Retinal fundus photograph, 45-degree field of view, image size 1932x1910:
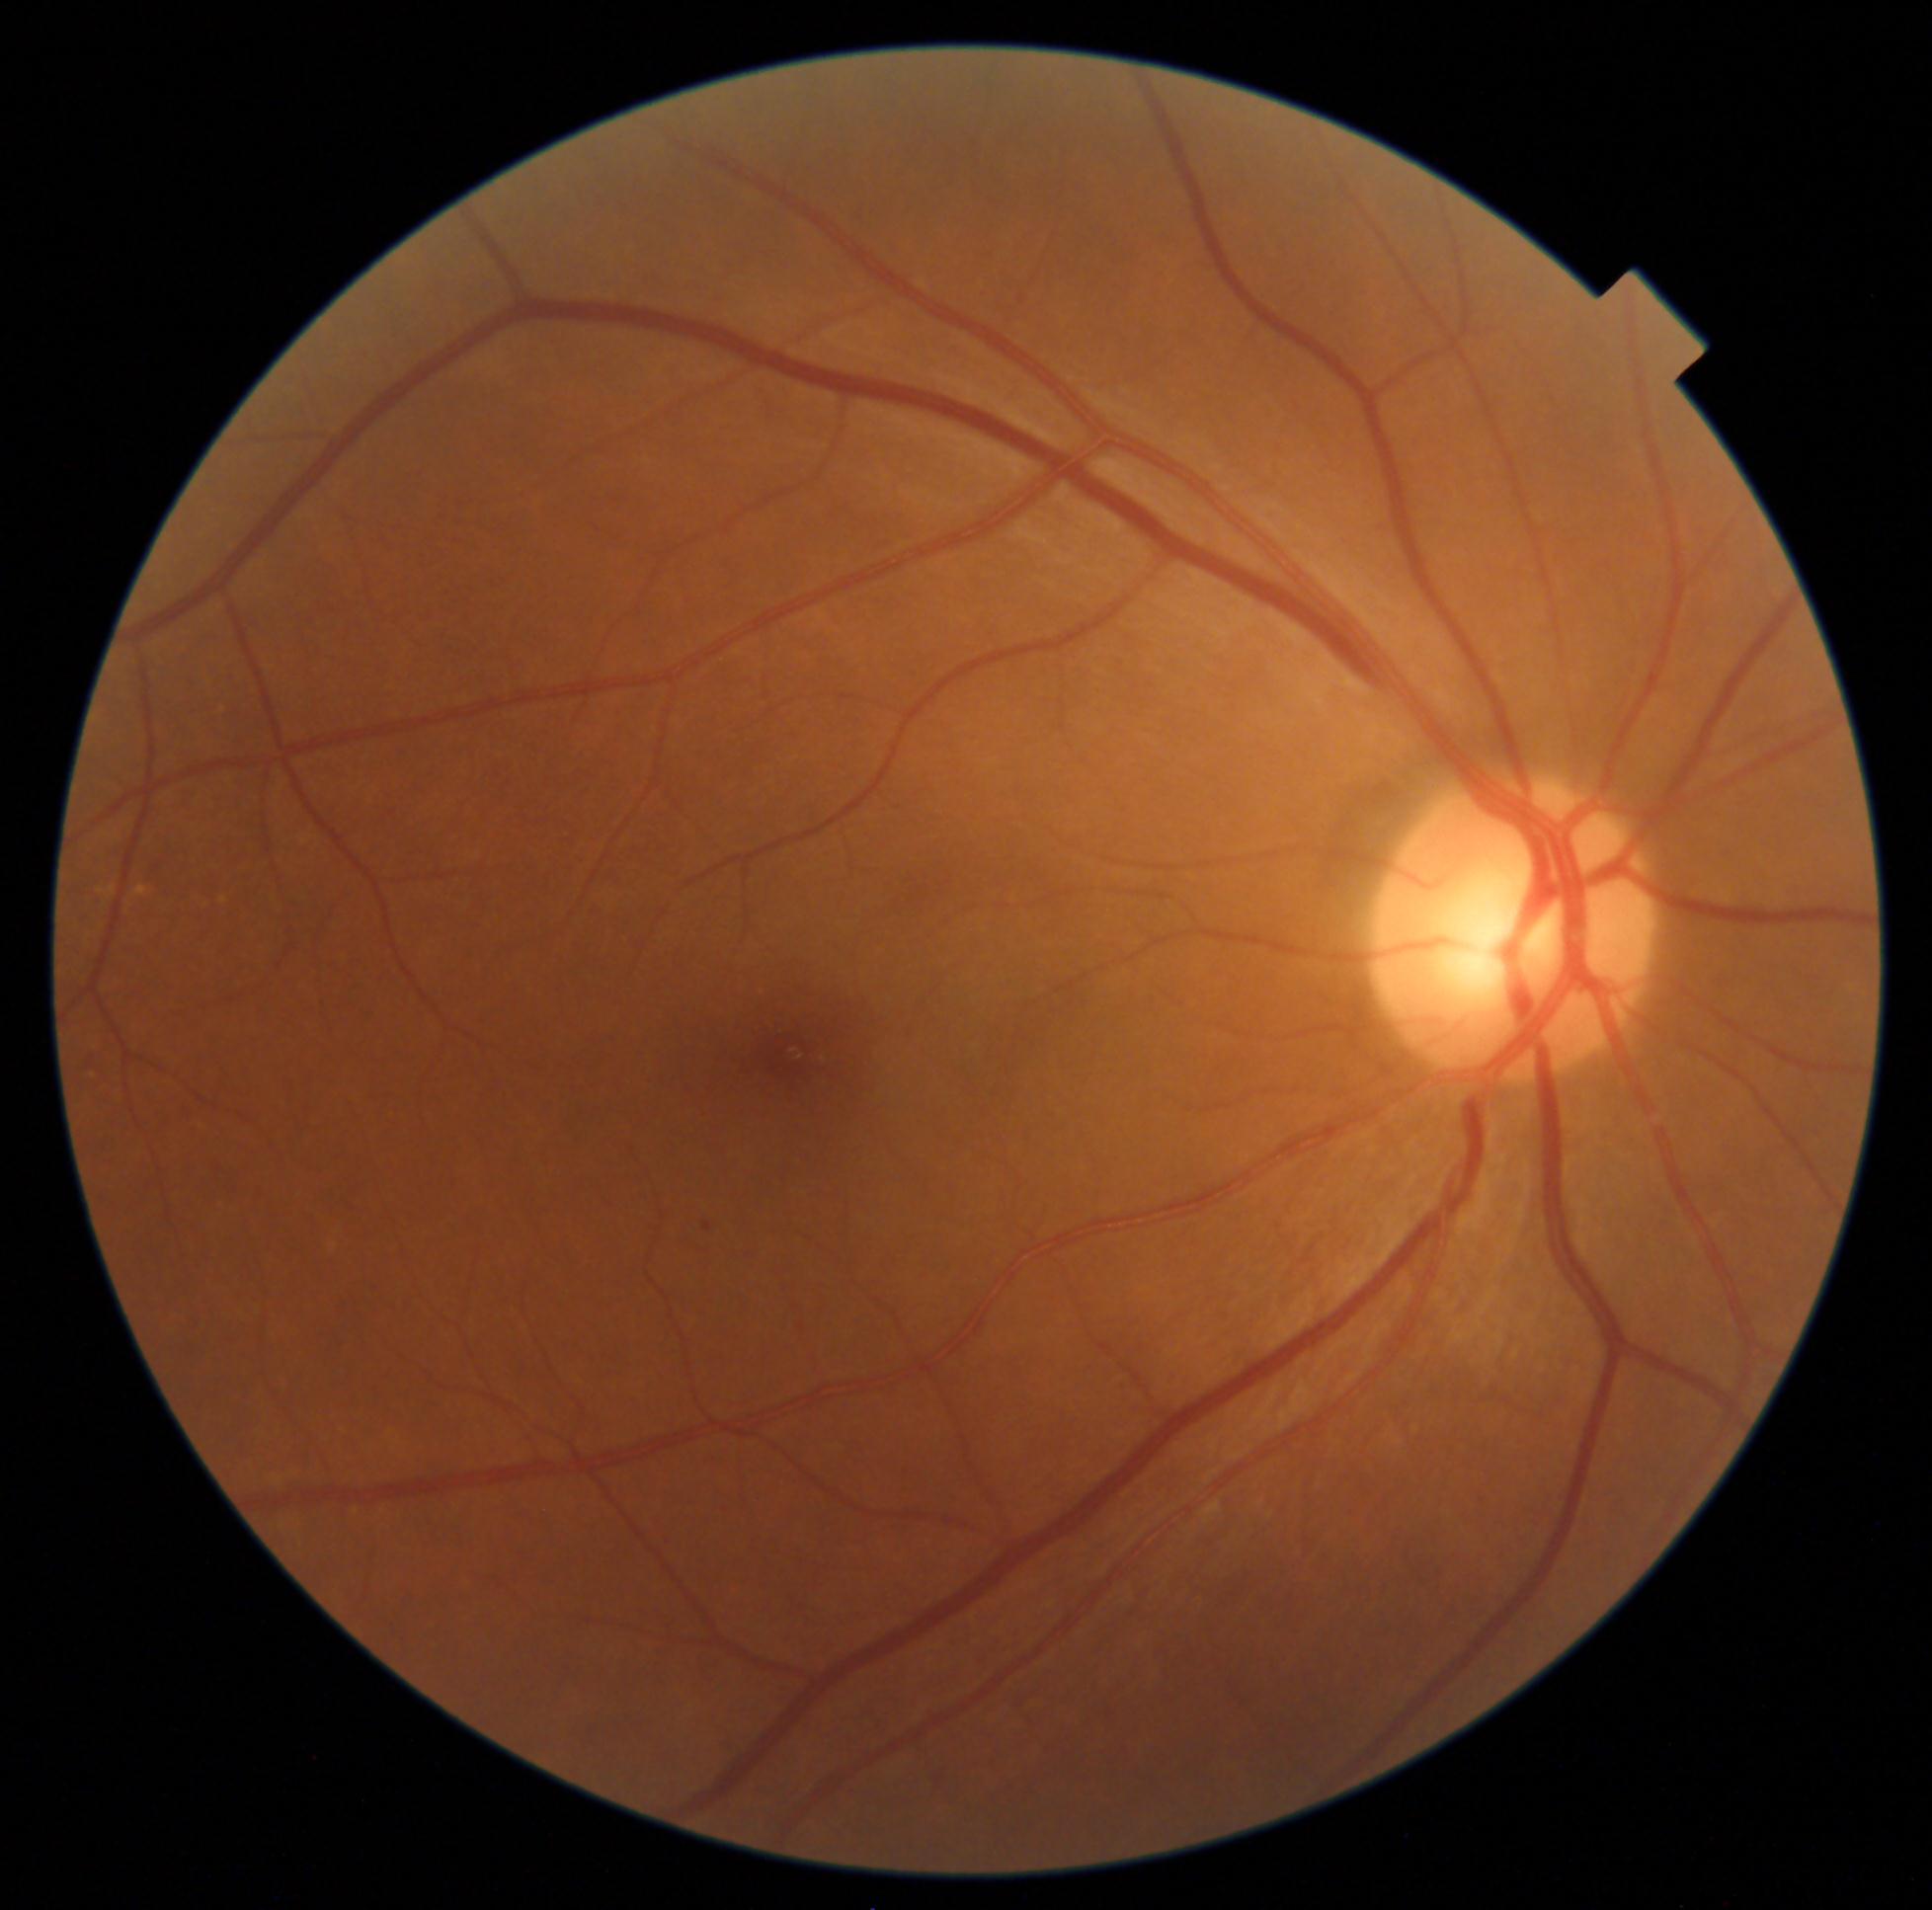 Diabetic retinopathy grade is 1/4.